1923x1932px; FOV: 45 degrees; CFP — 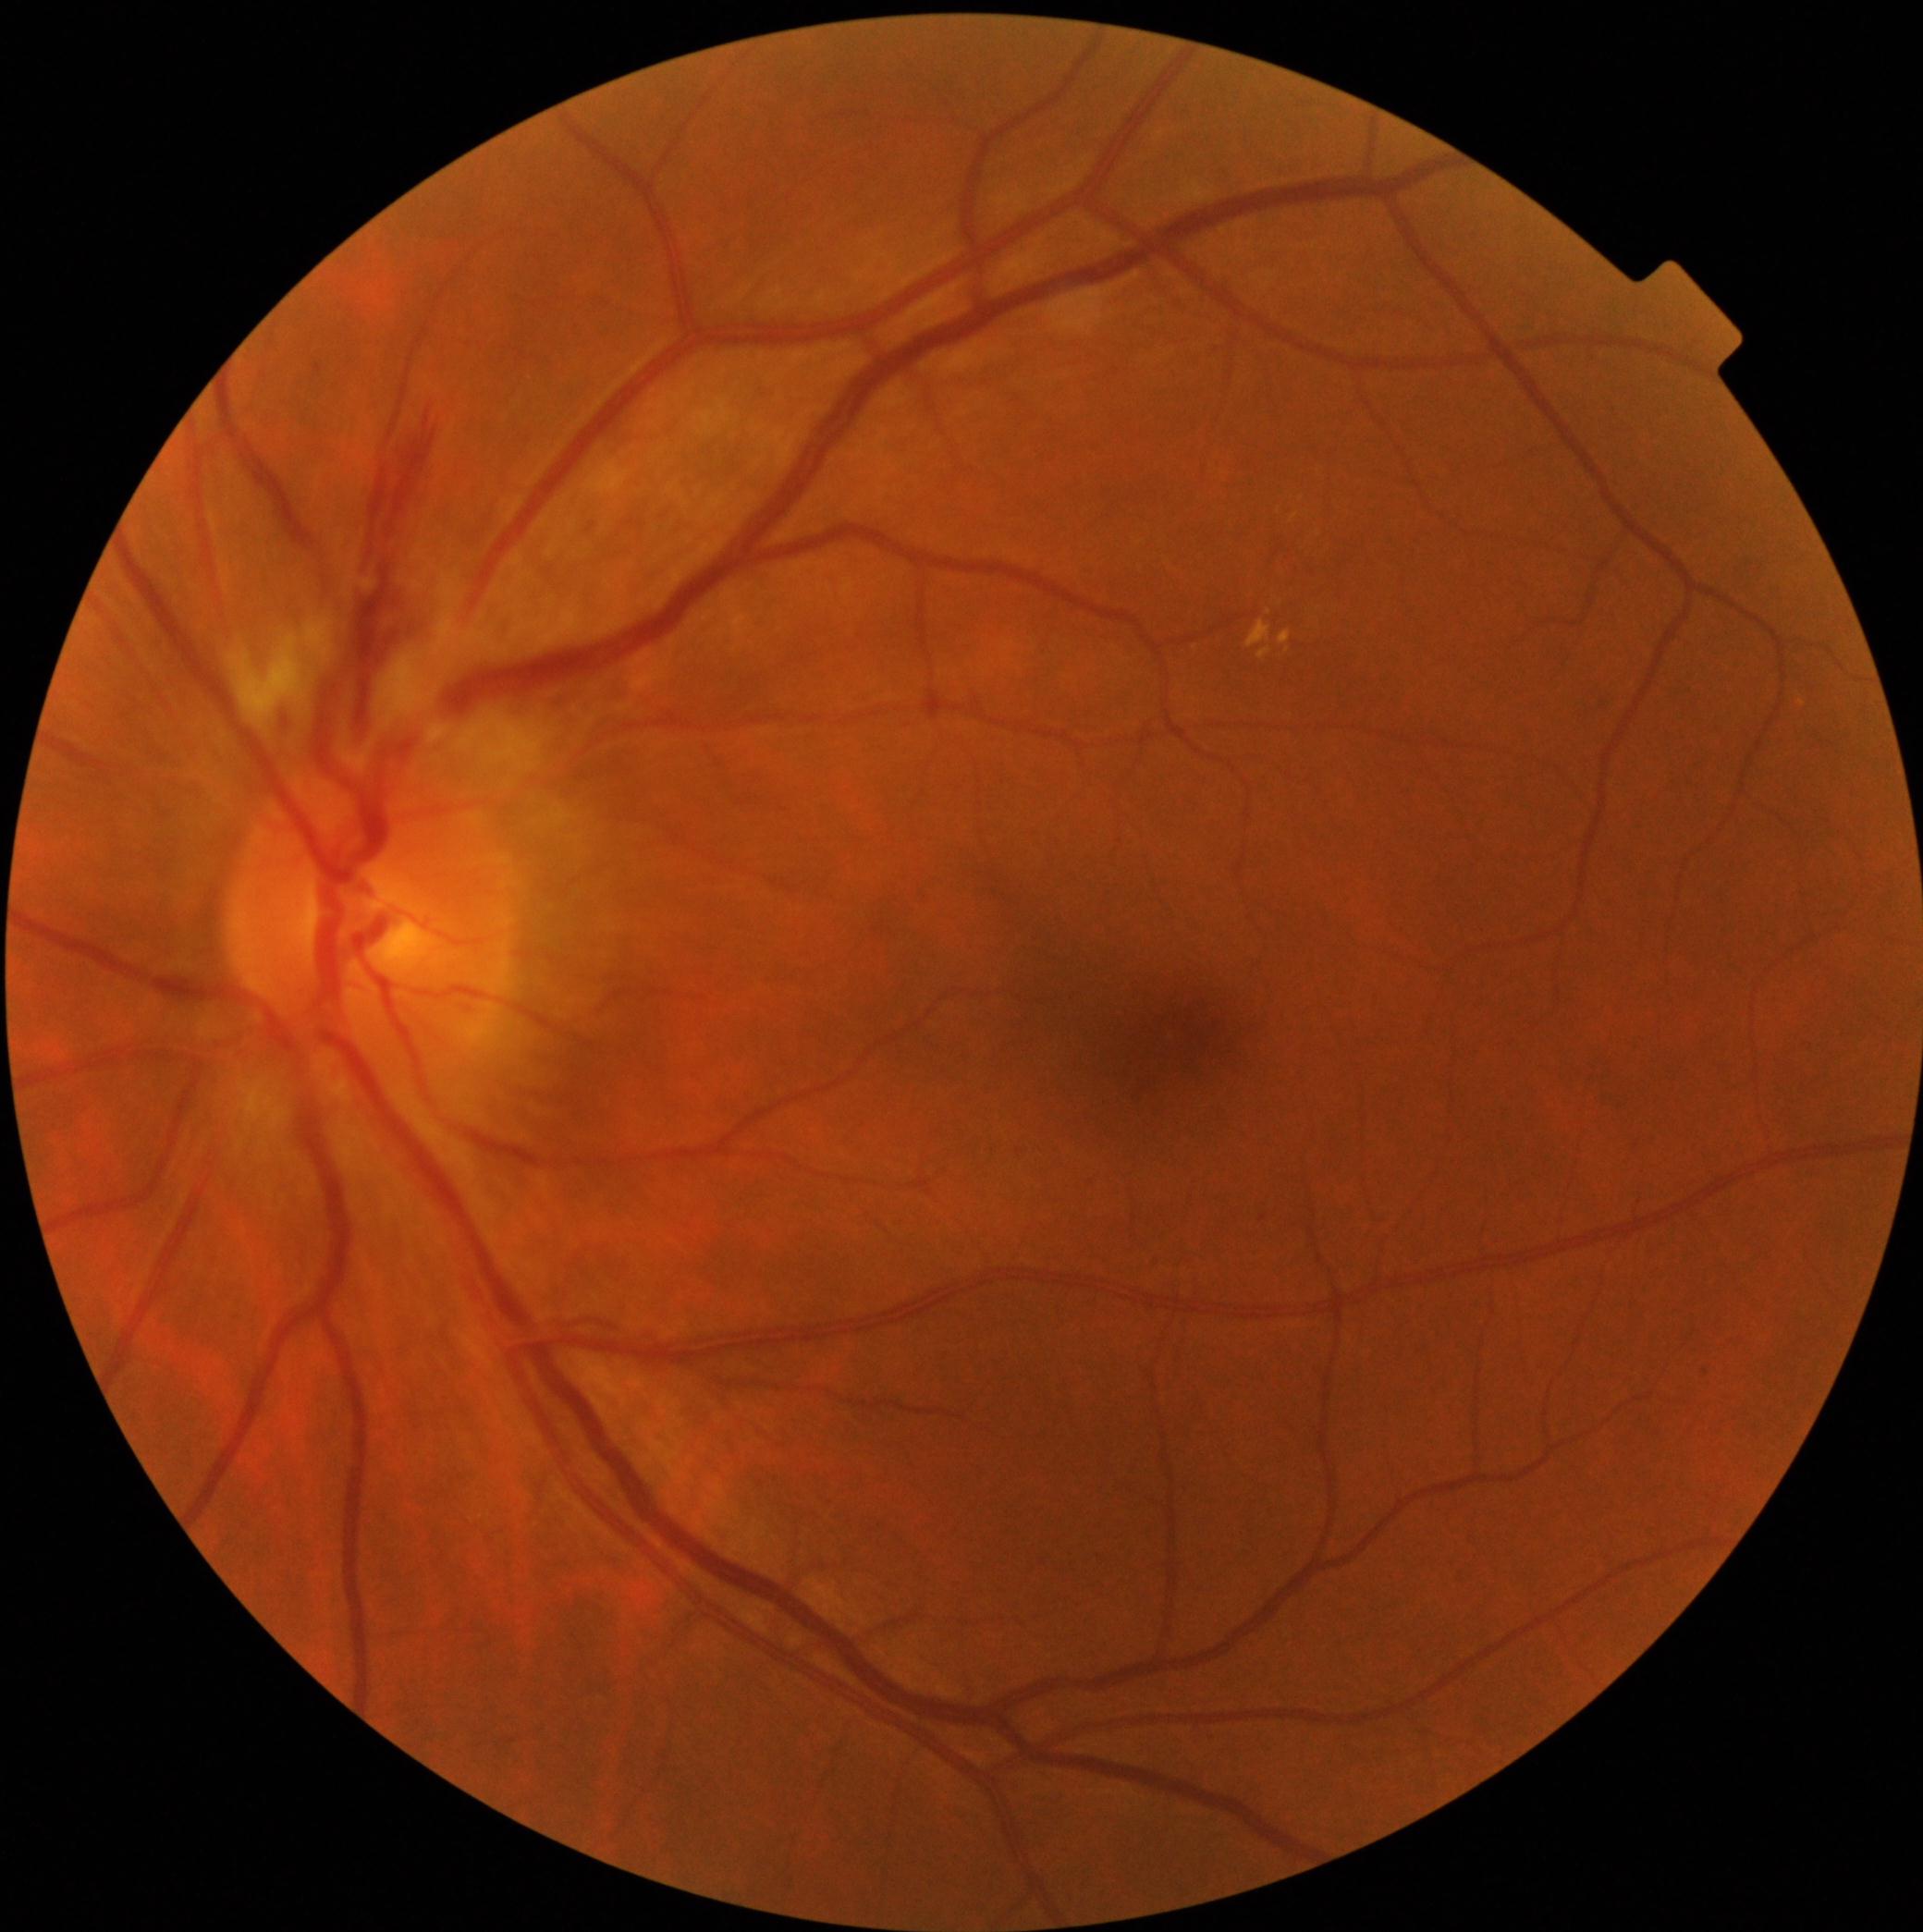 <lesions partial="true">
  <dr_grade>2</dr_grade>
  <ex>{"x1": 1258, "y1": 647, "x2": 1271, "y2": 661}, {"x1": 1247, "y1": 621, "x2": 1271, "y2": 649}, {"x1": 1280, "y1": 630, "x2": 1292, "y2": 645}</ex>
  <ex_small_centers>(1281; 603), (1289; 651), (1269; 614)</ex_small_centers>
  <ma>{"x1": 316, "y1": 366, "x2": 324, "y2": 373}</ma>
  <ma_small_centers>(1707; 1373), (1019; 1152)</ma_small_centers>
  <he partial="true">{"x1": 375, "y1": 580, "x2": 424, "y2": 661}, {"x1": 400, "y1": 410, "x2": 437, "y2": 514}, {"x1": 278, "y1": 692, "x2": 282, "y2": 722}</he>
  <se>{"x1": 229, "y1": 619, "x2": 353, "y2": 718}, {"x1": 419, "y1": 698, "x2": 565, "y2": 788}</se>
</lesions>